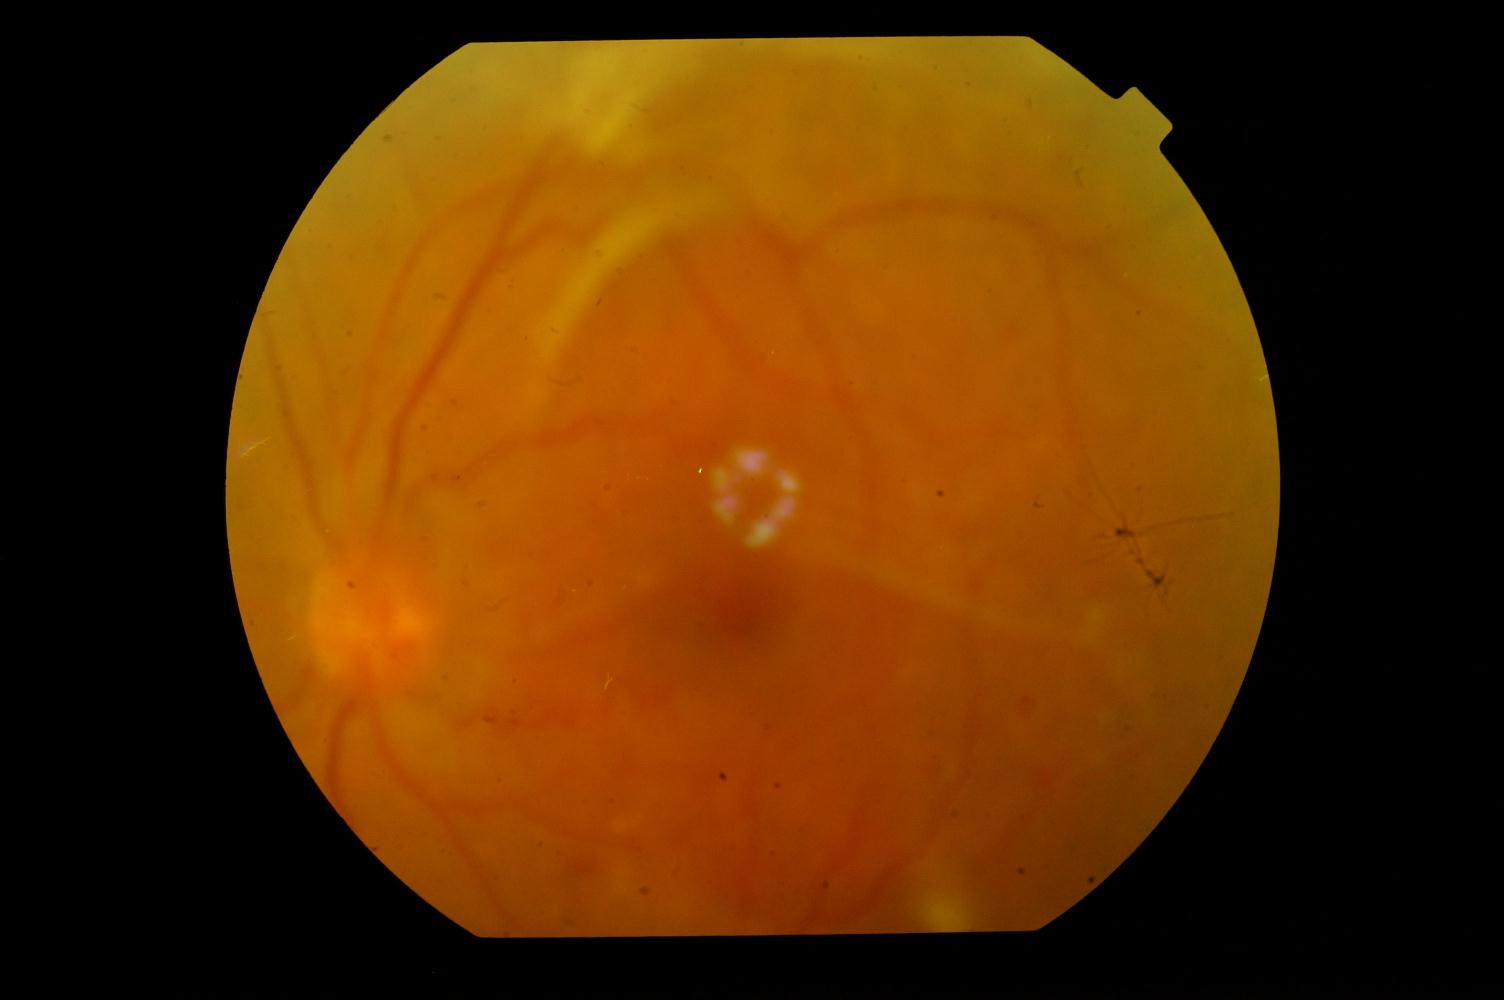 Color fundus photograph showing diabetic retinopathy.